Acquired with a NIDEK AFC-230:
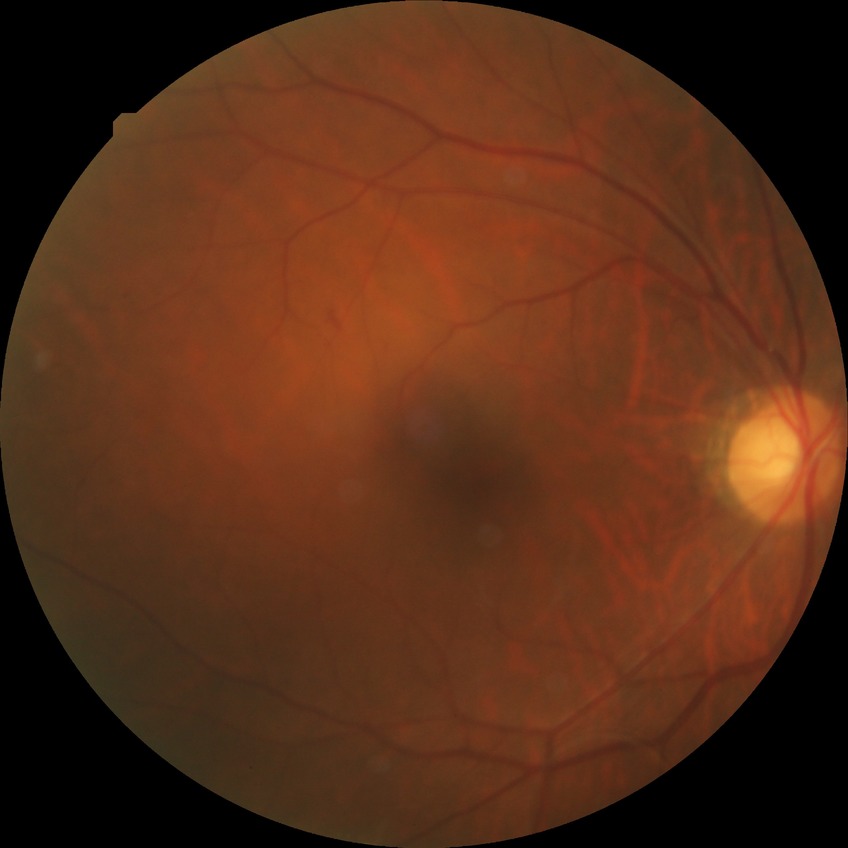 Findings:
* DR class: non-proliferative diabetic retinopathy
* modified Davis classification: simple diabetic retinopathy